Wide-field fundus photograph of an infant. Image size 640x480:
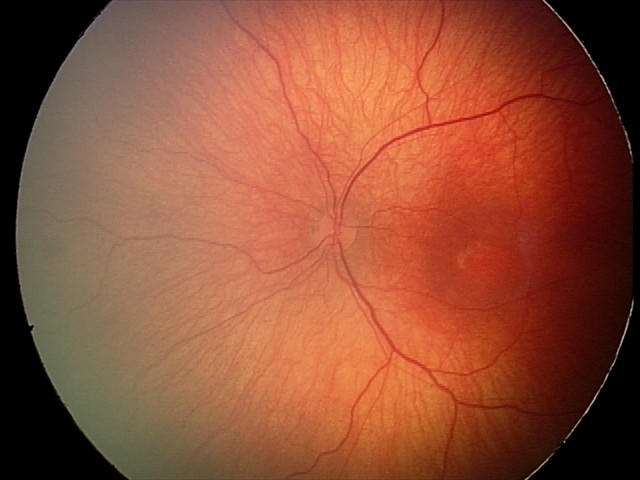

Series diagnosed as ROP stage 1.